Captured with the Clarity RetCam 3 (130° field of view) · 640x480 · pediatric retinal photograph (wide-field): 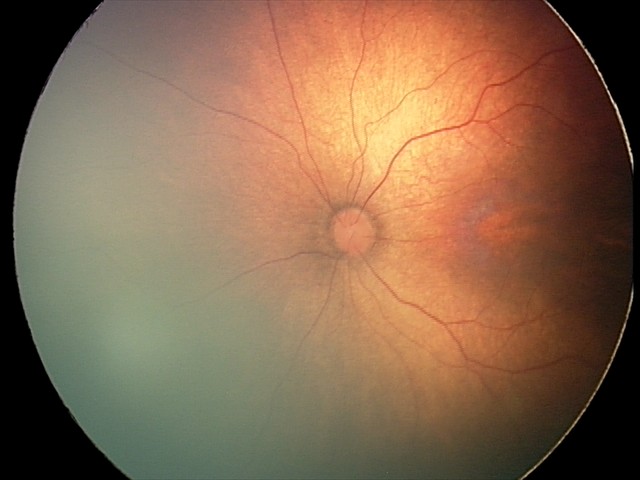
Series diagnosed as status post retinopathy of prematurity.